FOV: 45 degrees, color fundus image
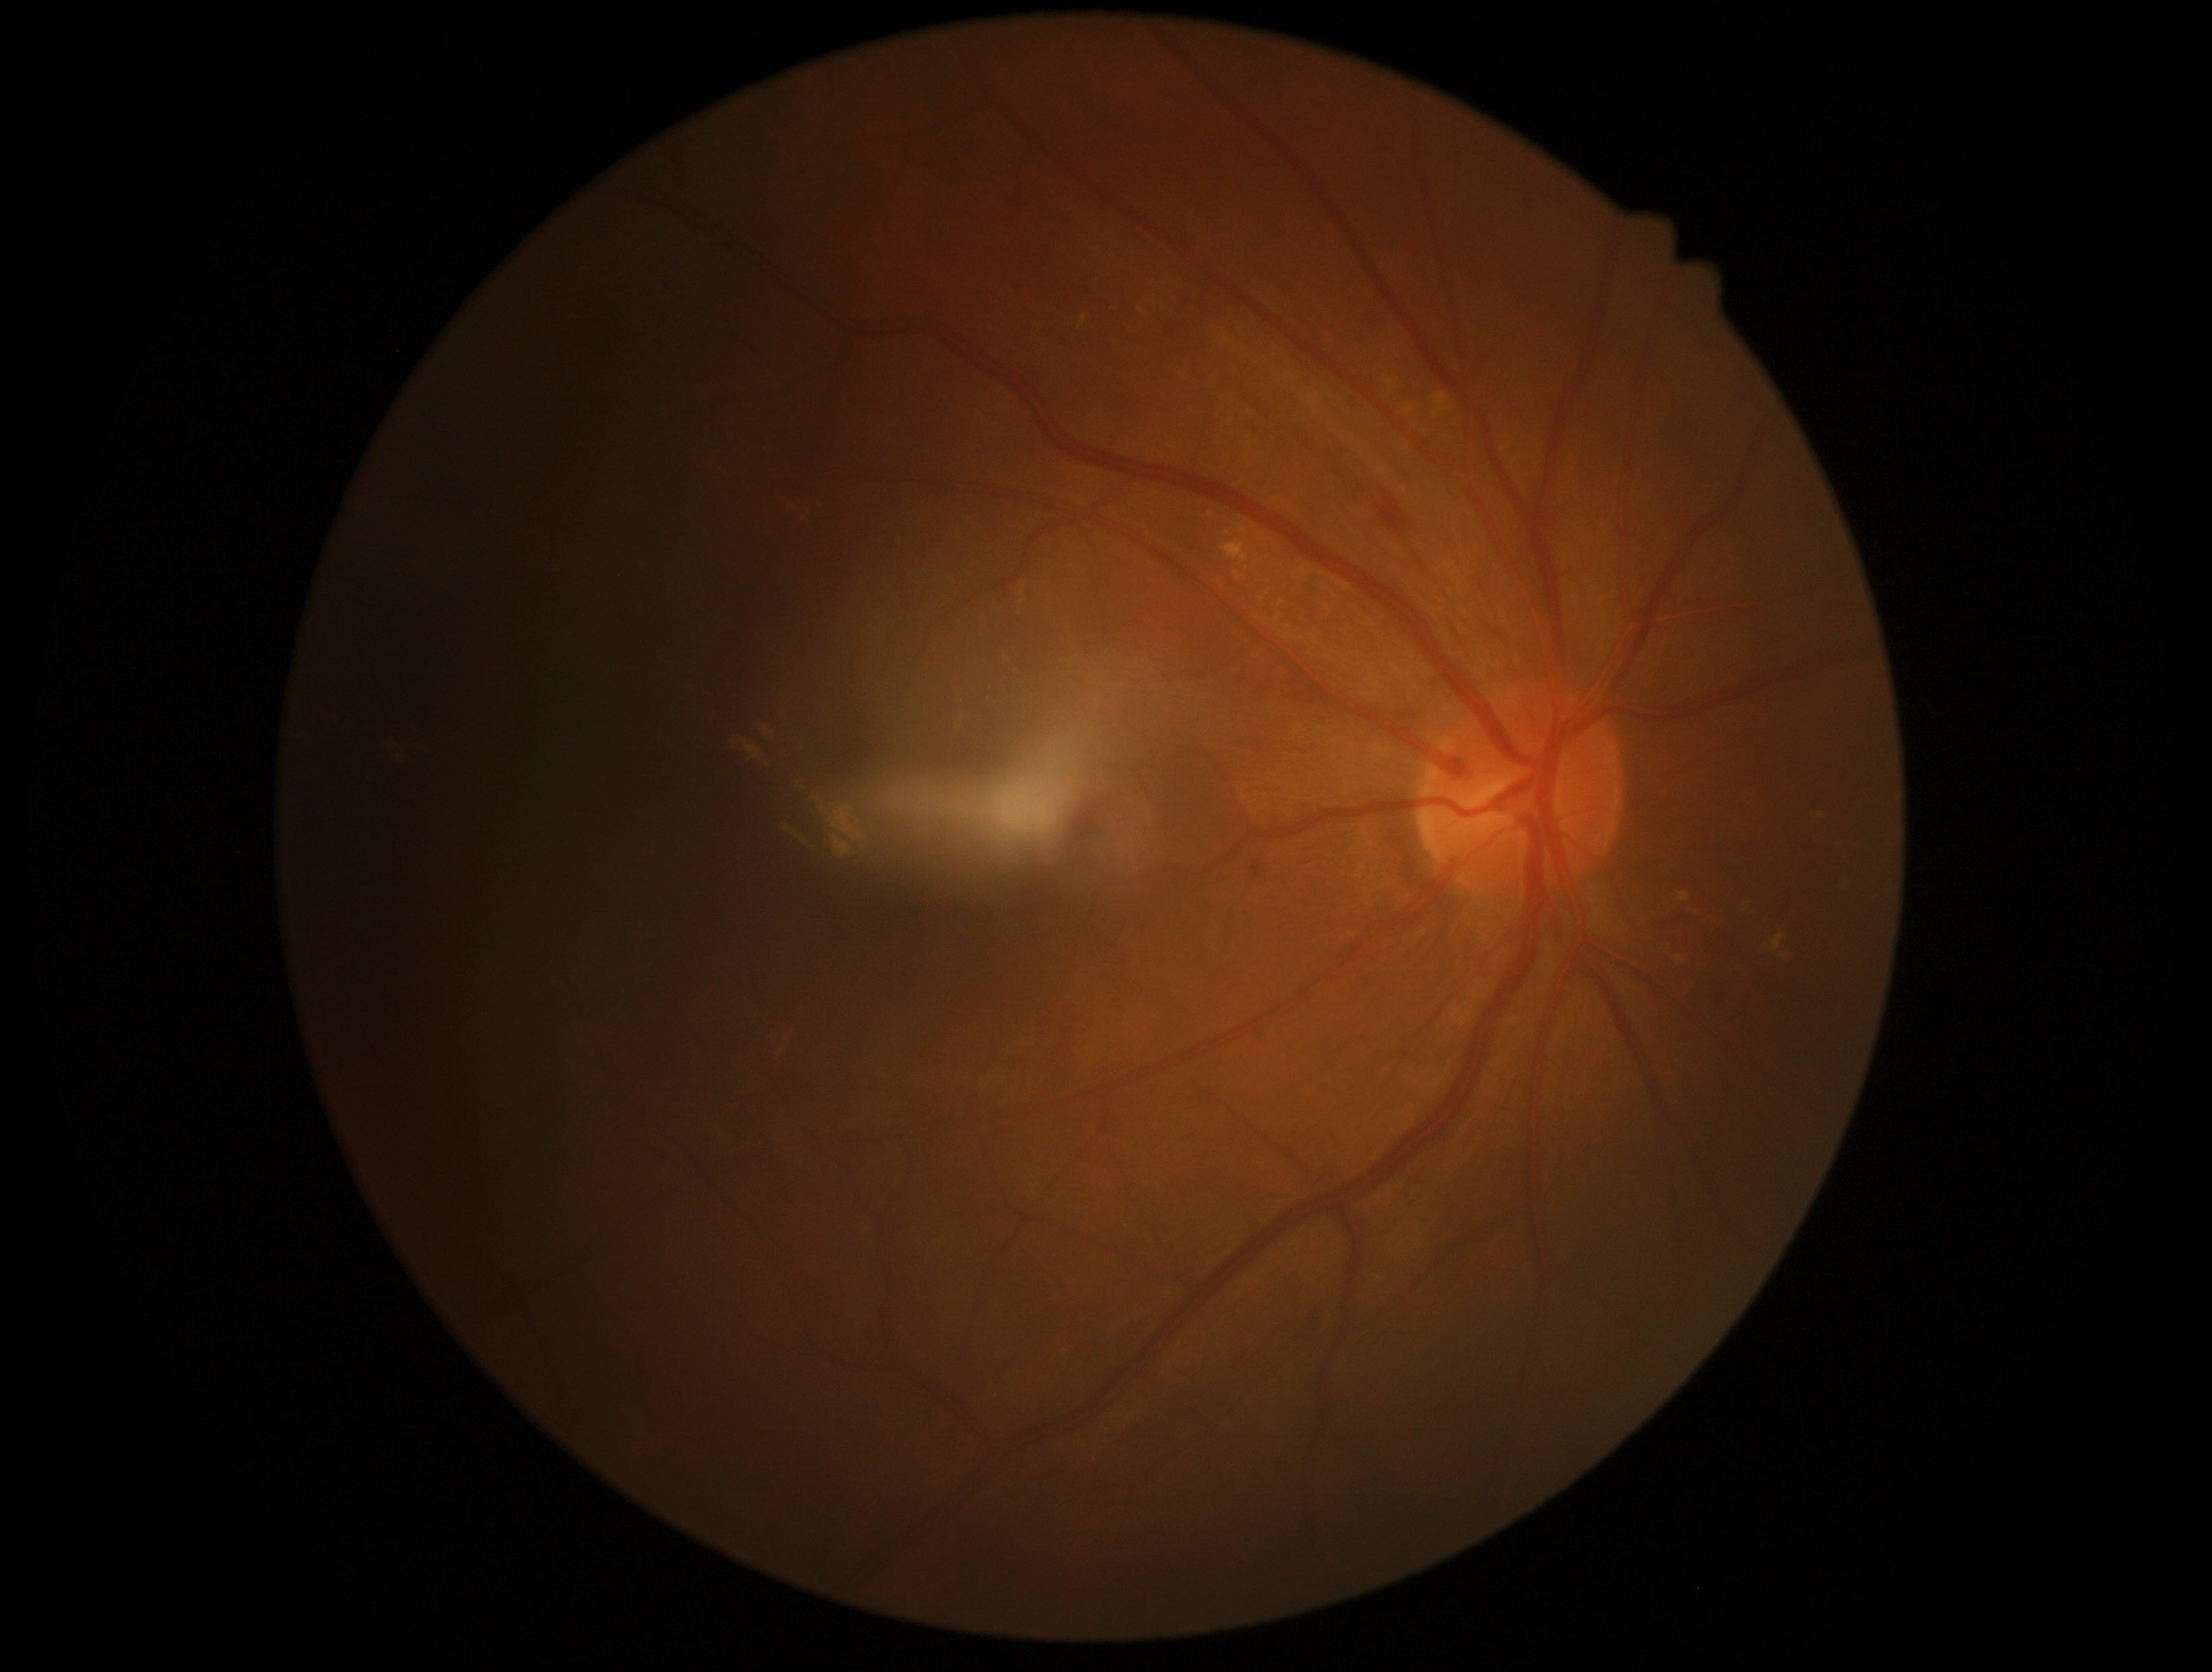
DR grade: 2 (moderate NPDR) — more than just microaneurysms but less than severe NPDR.